Fundus photo, 45° FOV: 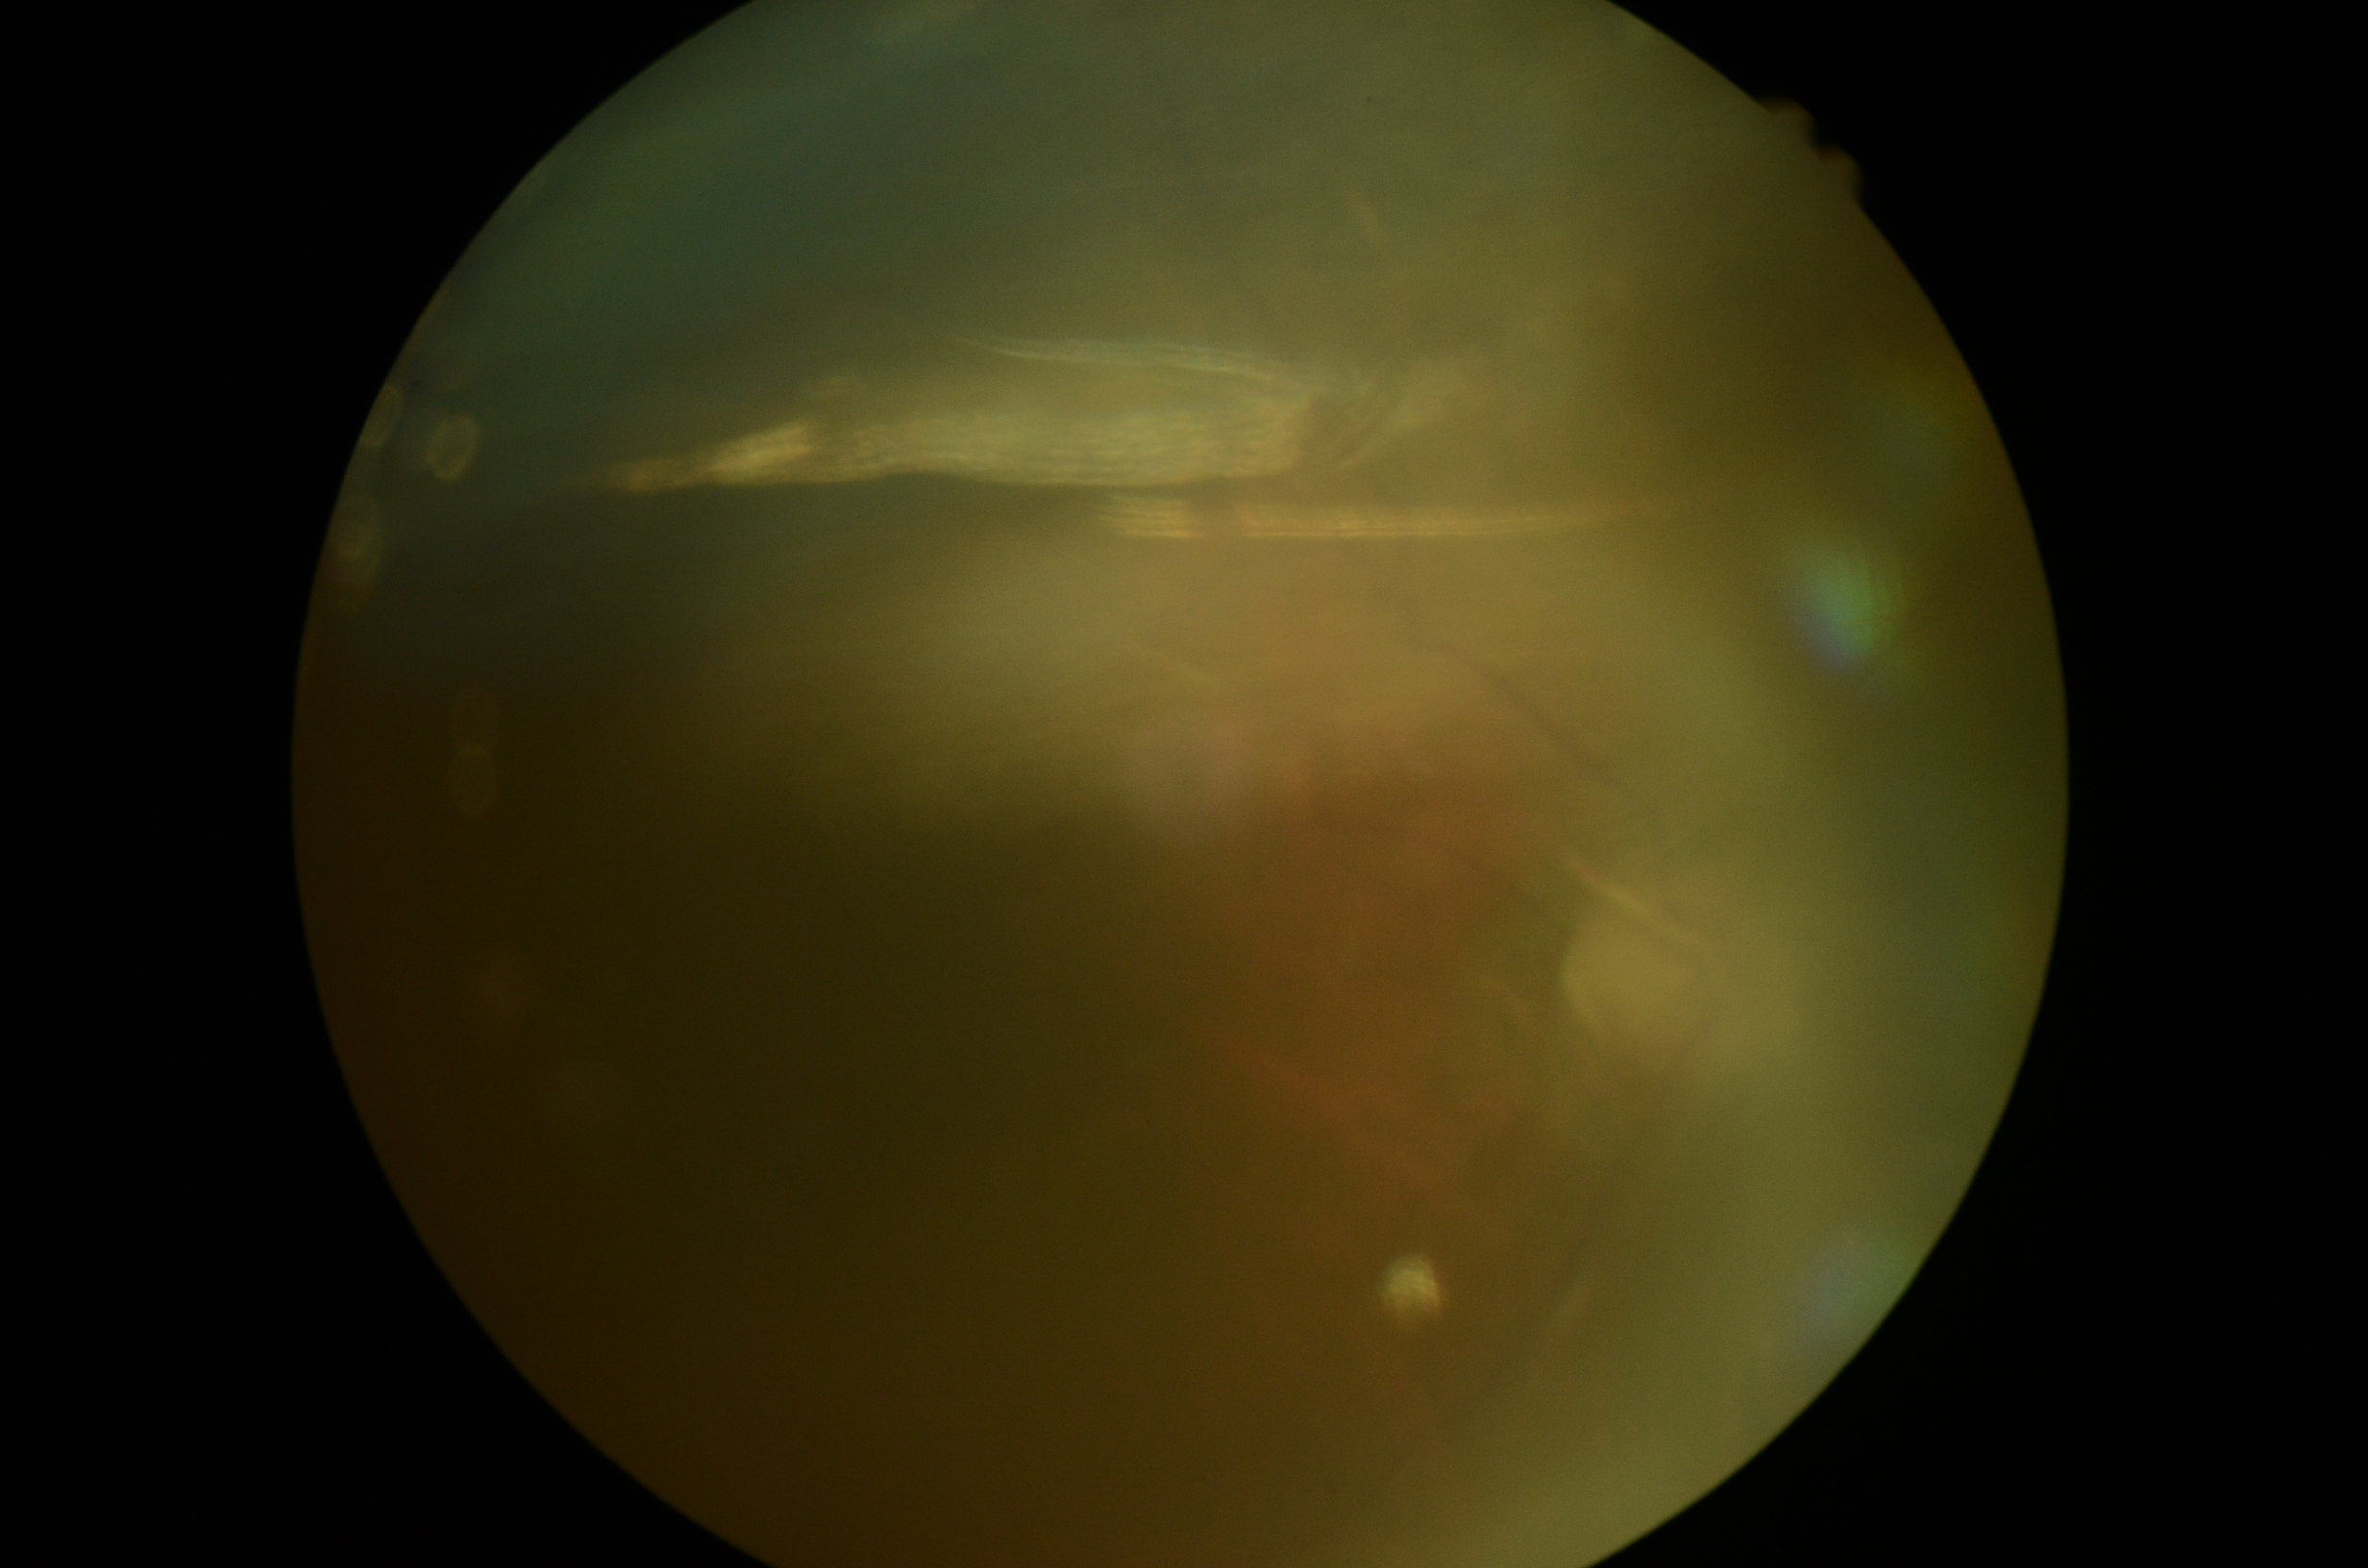
diabetic retinopathy@ungradable, image quality@too poor for DR grading.